Color fundus photograph, centered on the macula:
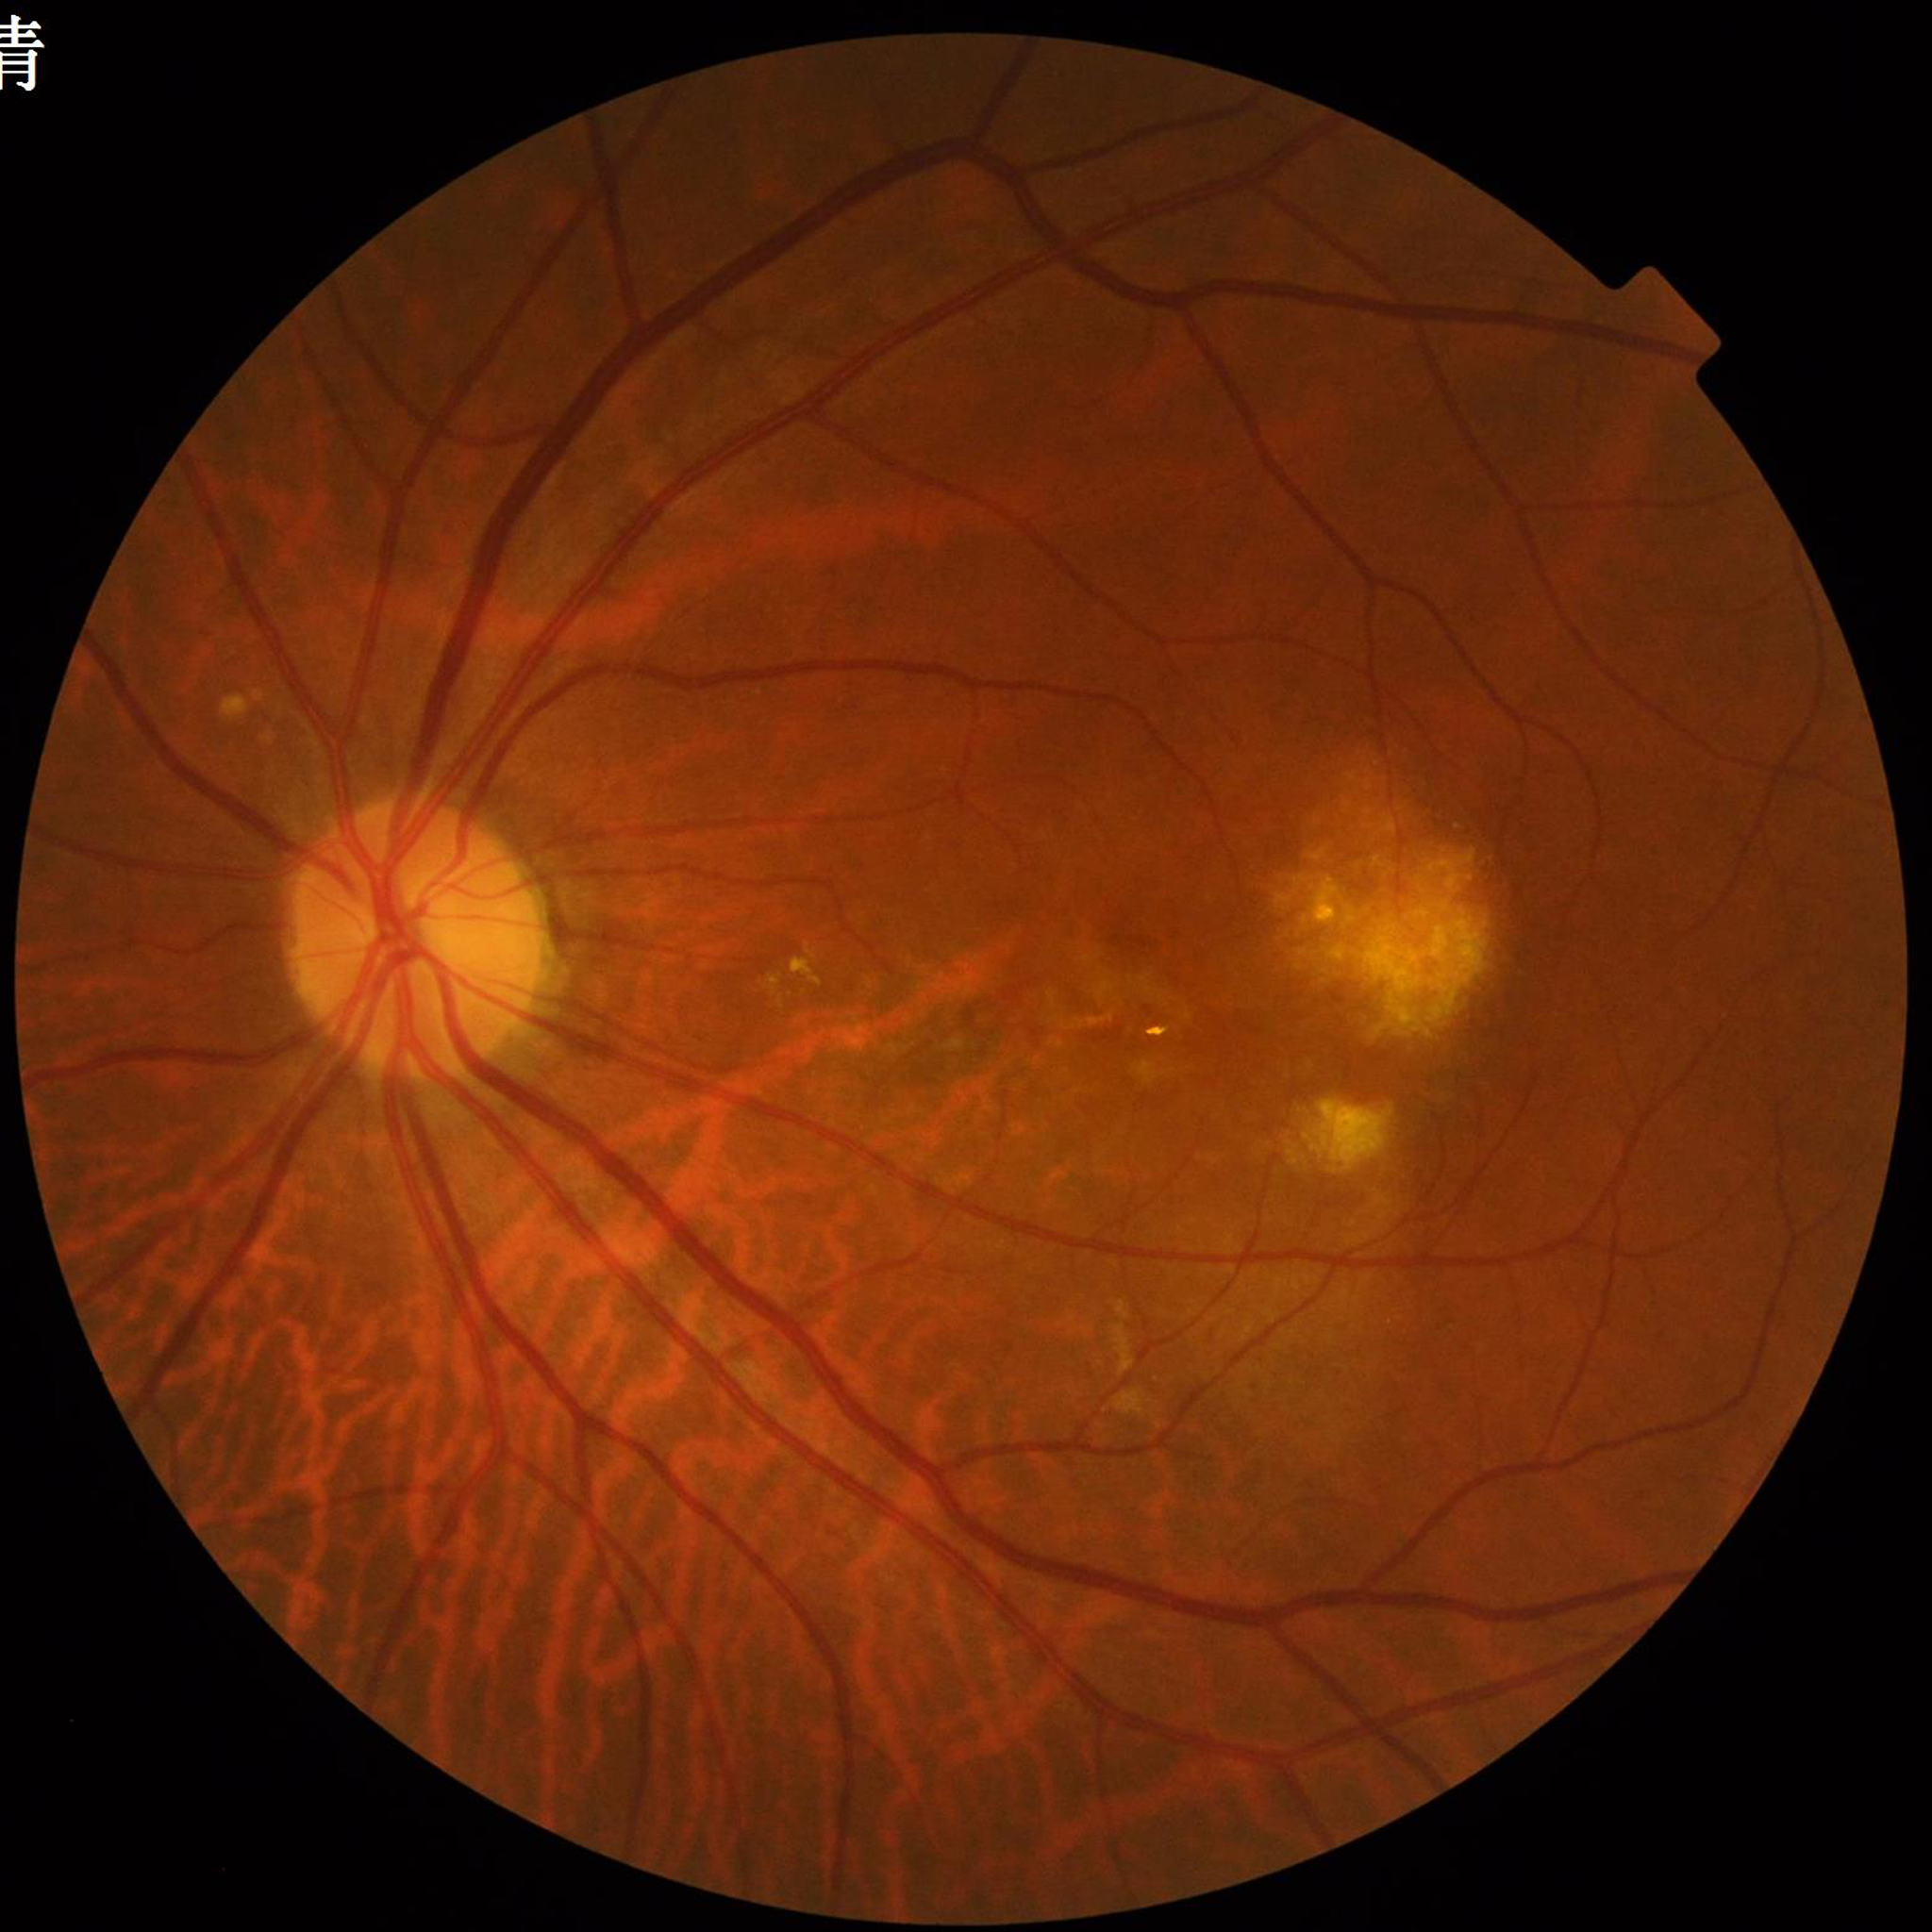
  image_quality: contrast adequate, illumination and color satisfactory, no blur
  diagnosis: age-related macular degeneration (AMD)